Color fundus photograph, 45-degree field of view, 1380 by 1382 pixels:
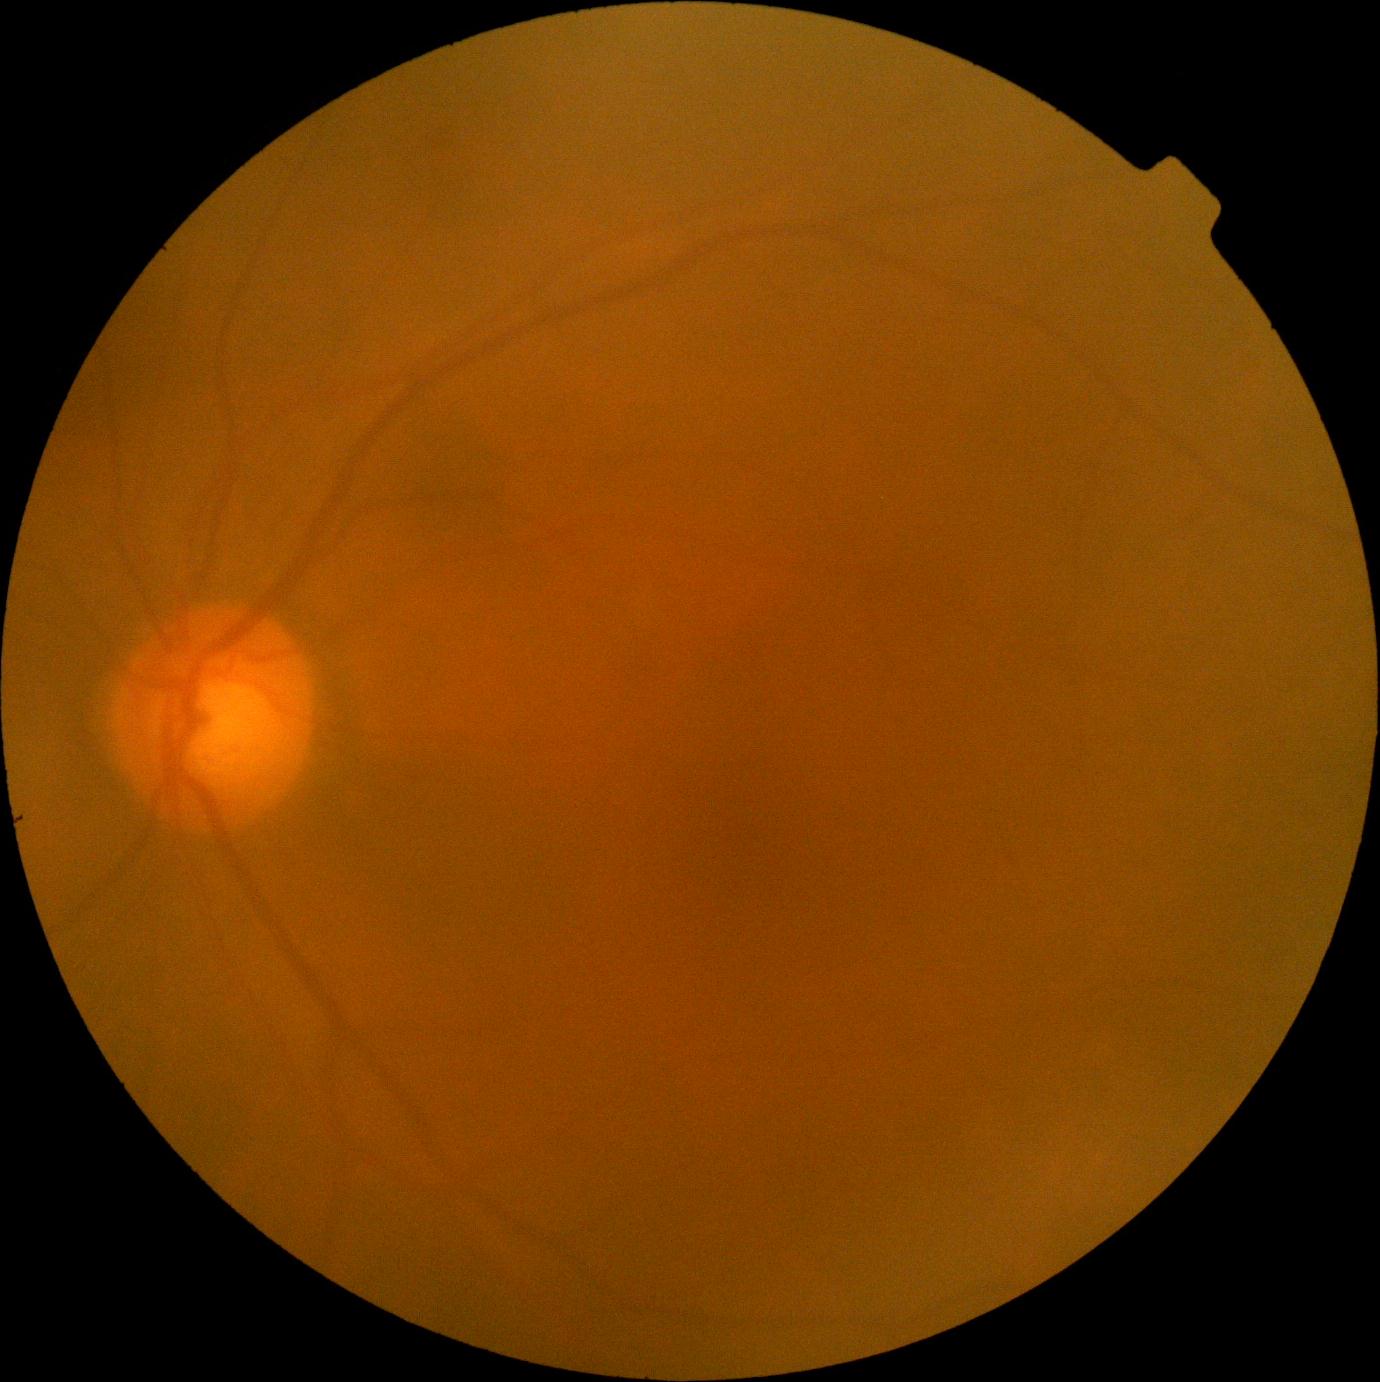

DR: no apparent retinopathy (grade 0) — no visible signs of diabetic retinopathy.